2212x1659; 60-degree field of view; portable fundus camera image.
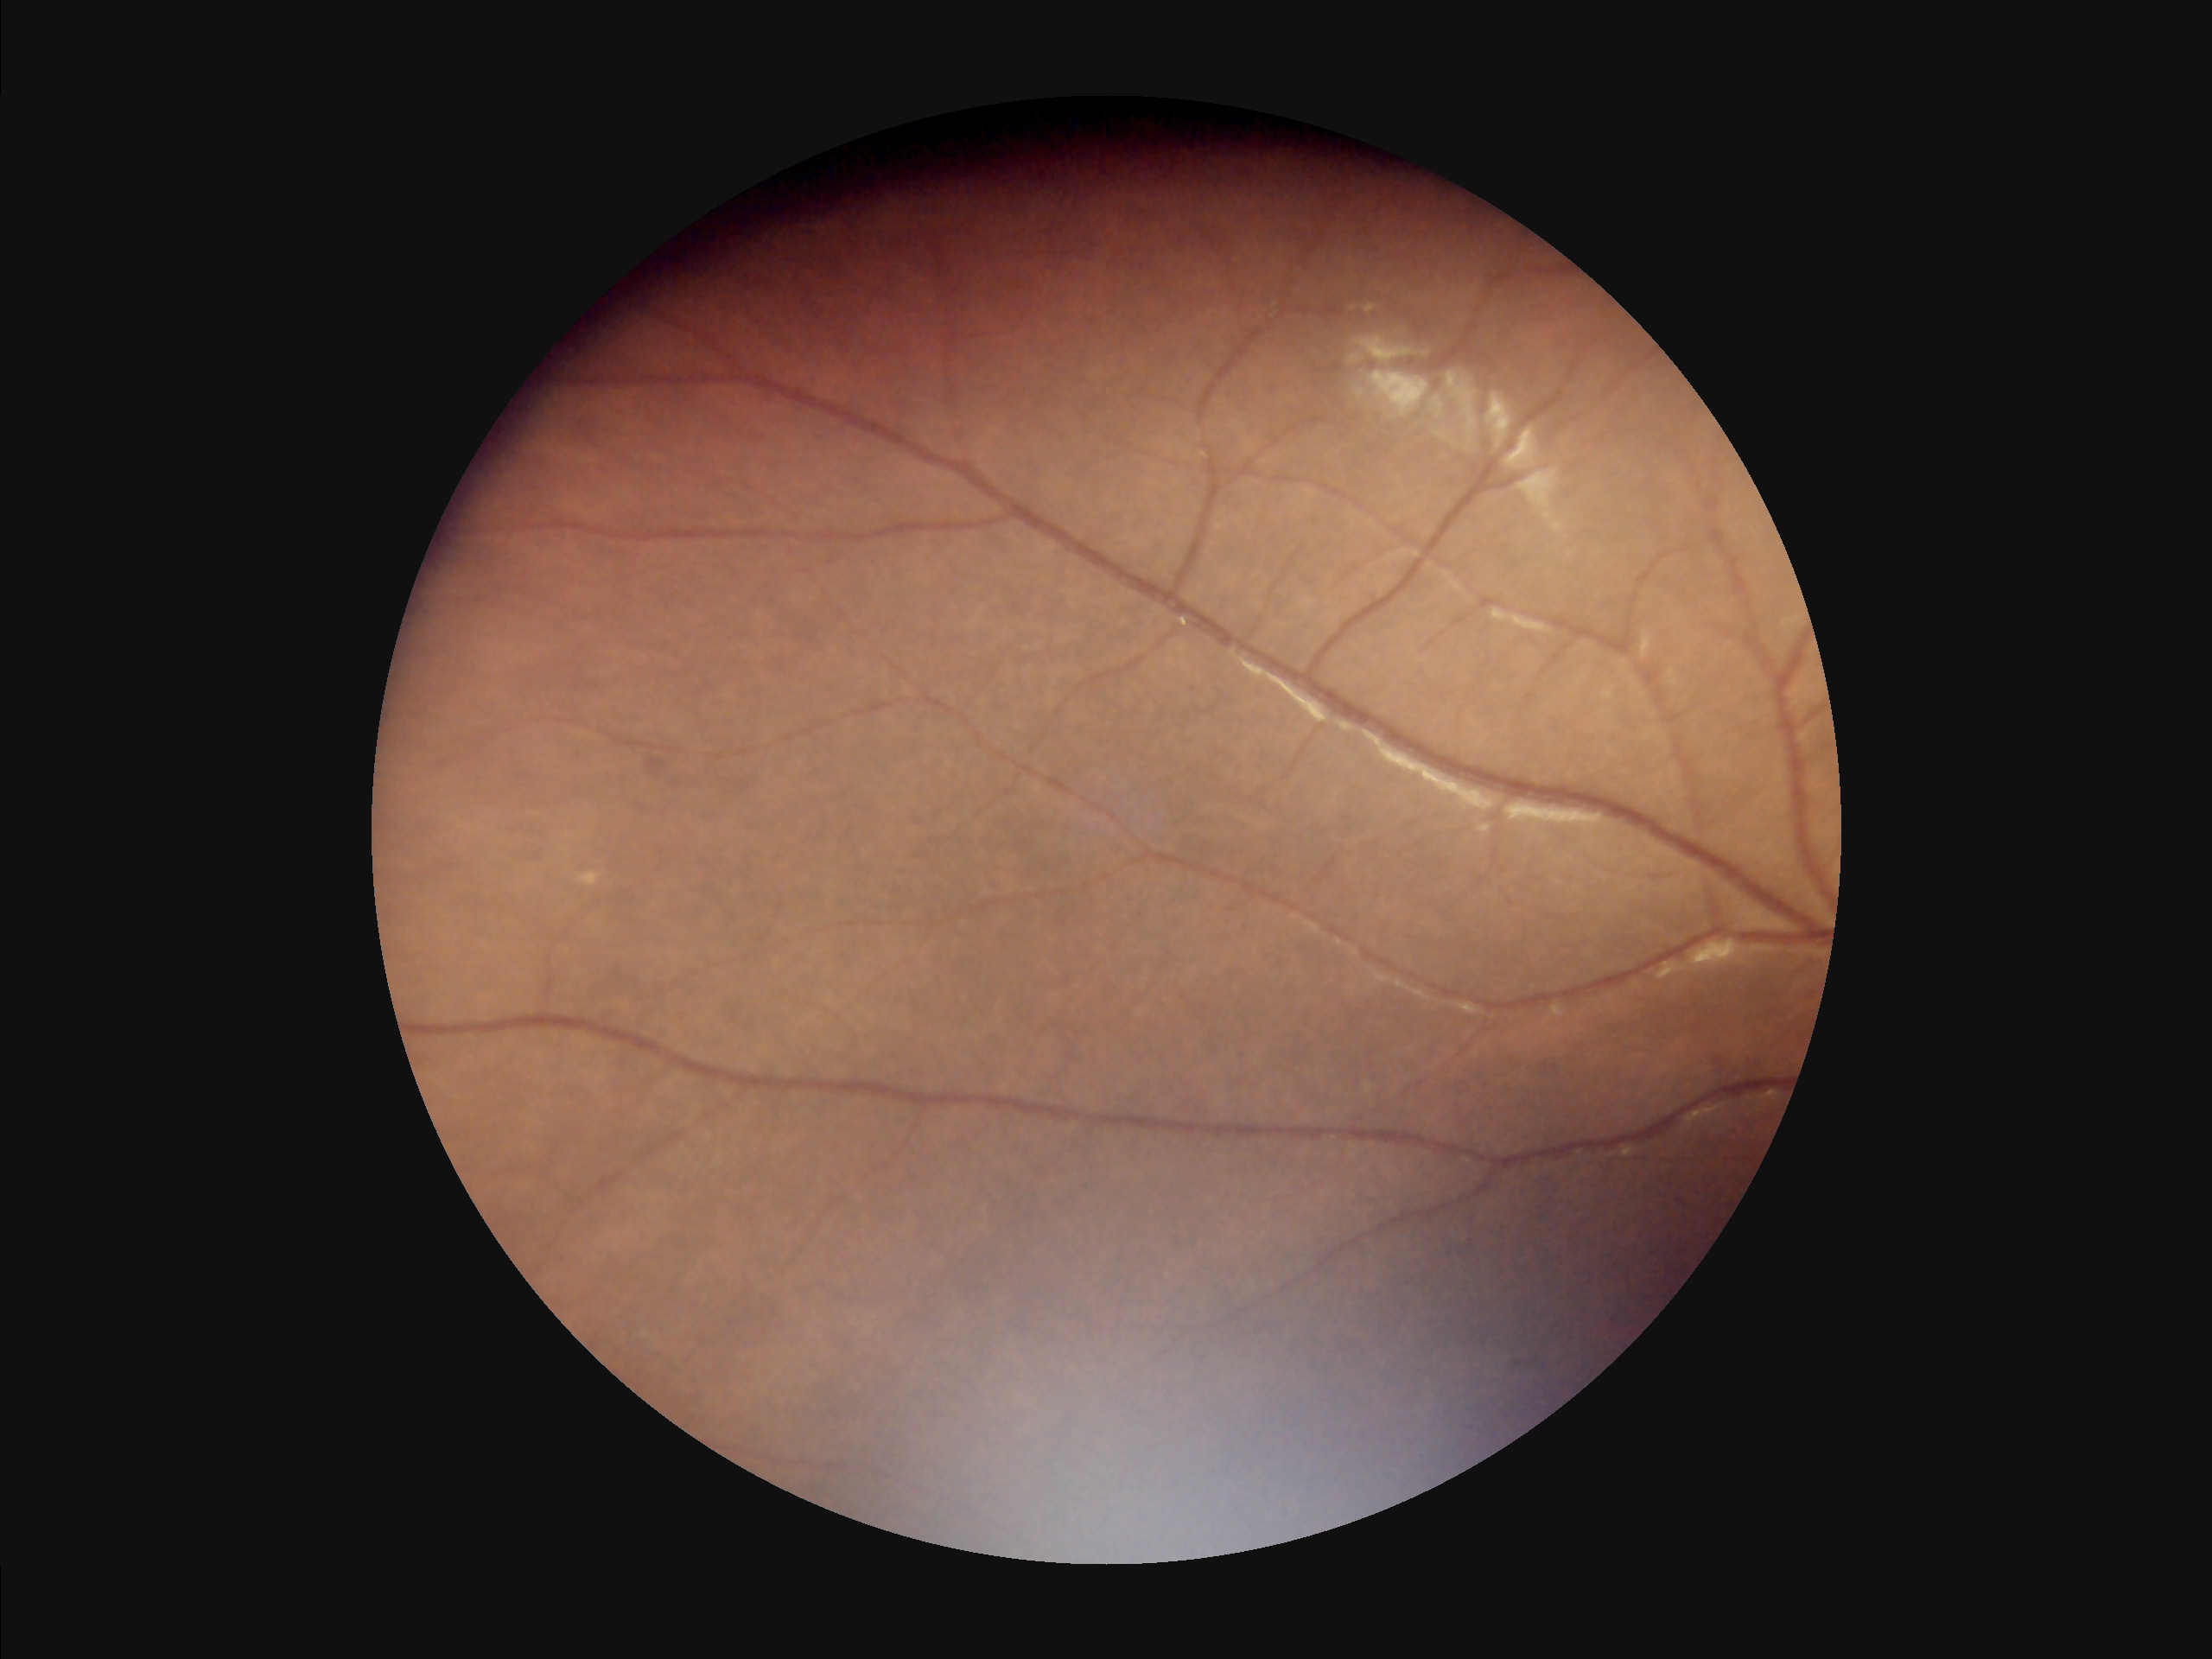 {"overall_quality": "low", "illumination": "poor", "clarity": "good", "contrast": "low"}